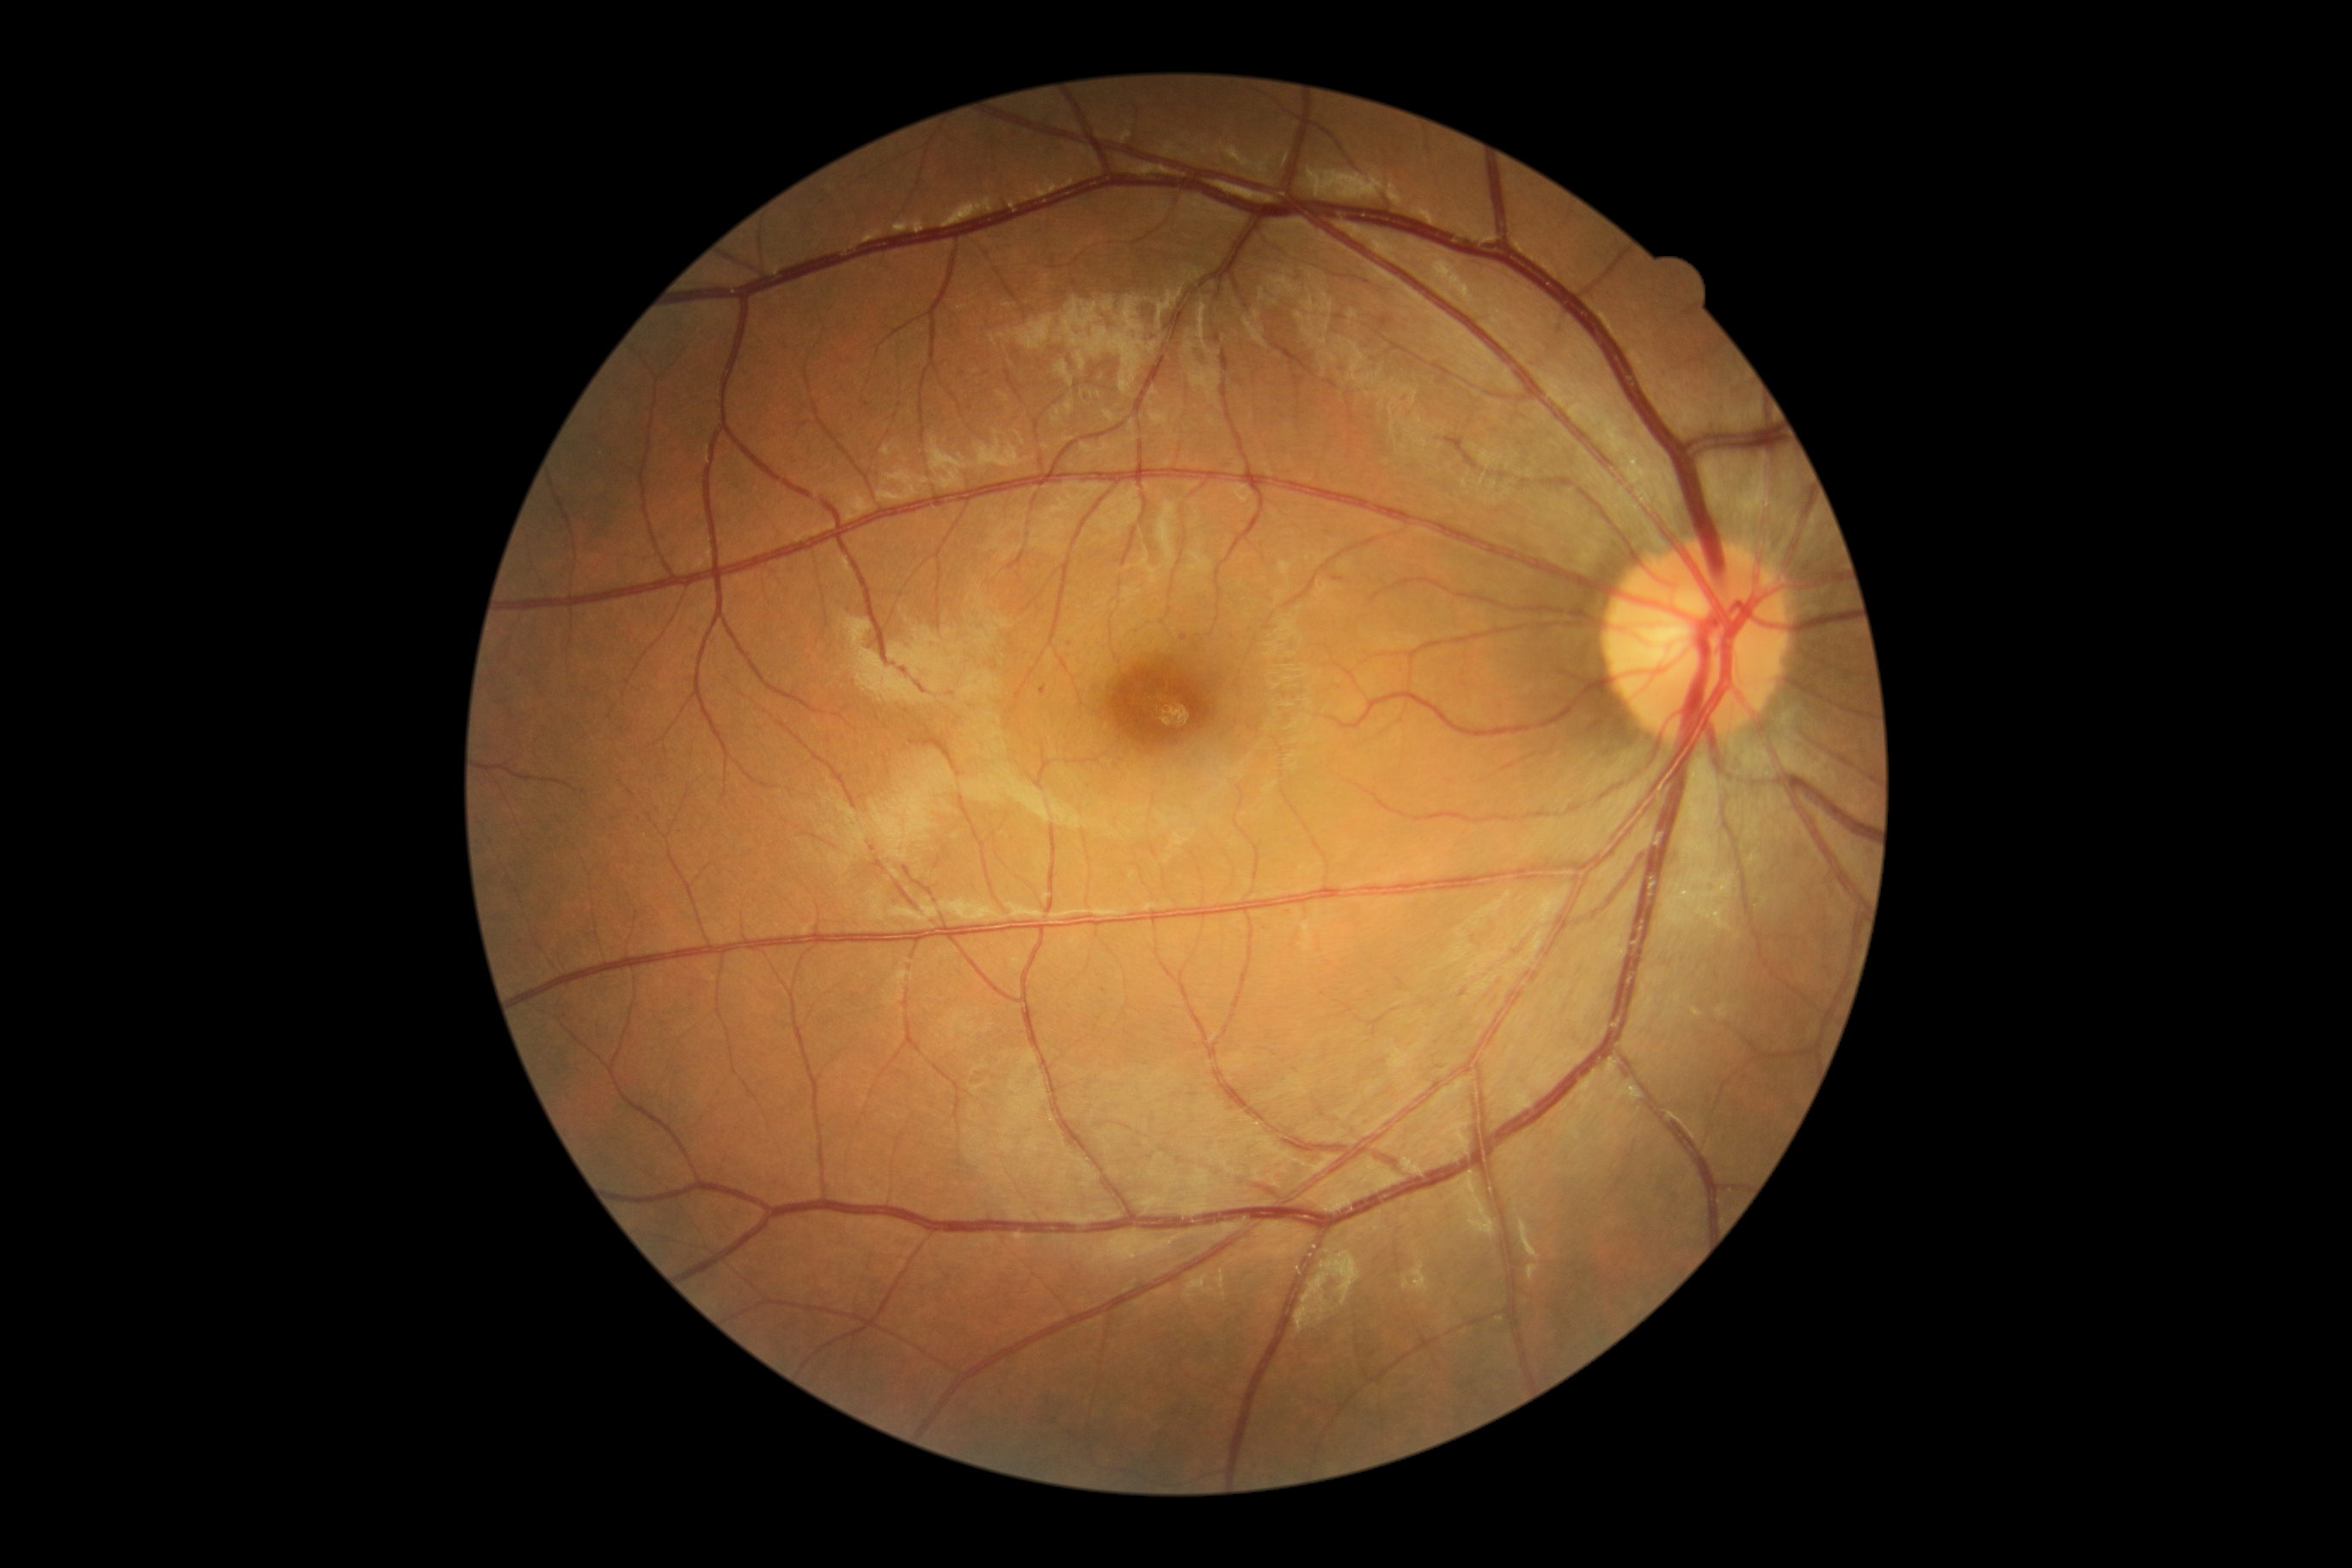
DR grade=1.